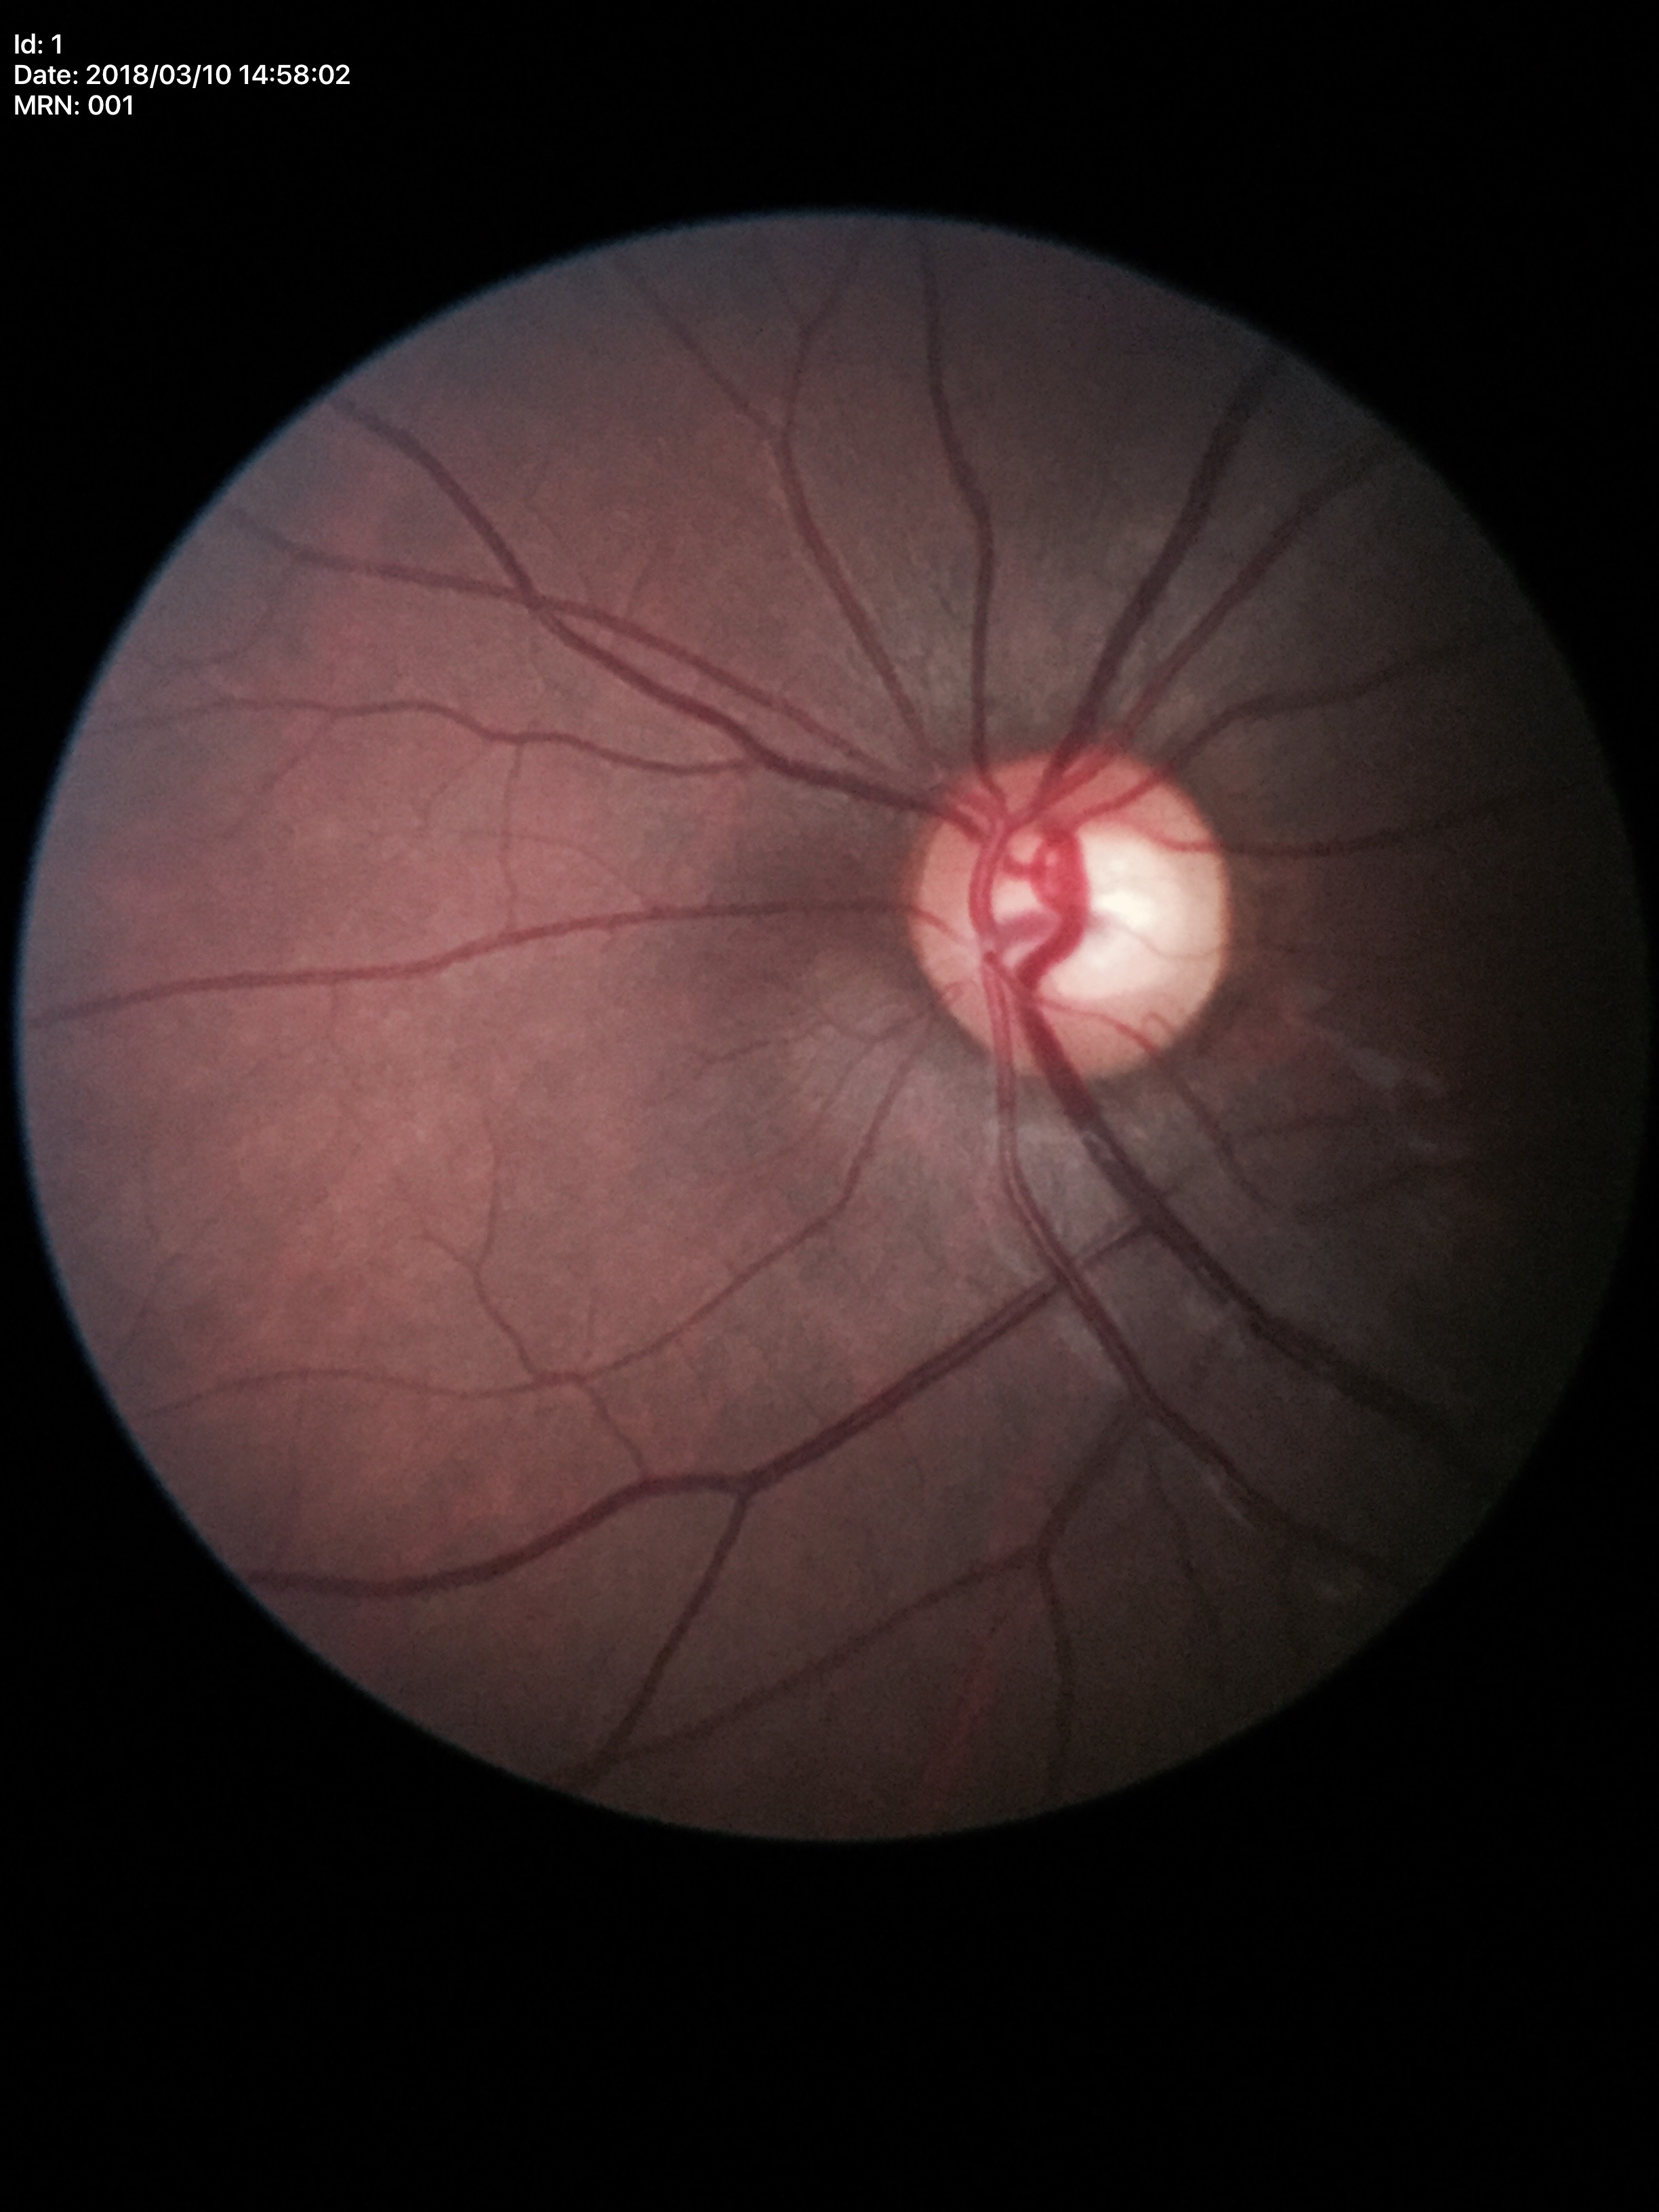

Glaucoma screening impression: suspect (four of five ophthalmologists flagged glaucoma suspect) | vertical C/D ratio: 0.63 | horizontal C/D ratio: 0.69.